NIDEK AFC-230 fundus camera; without pupil dilation — 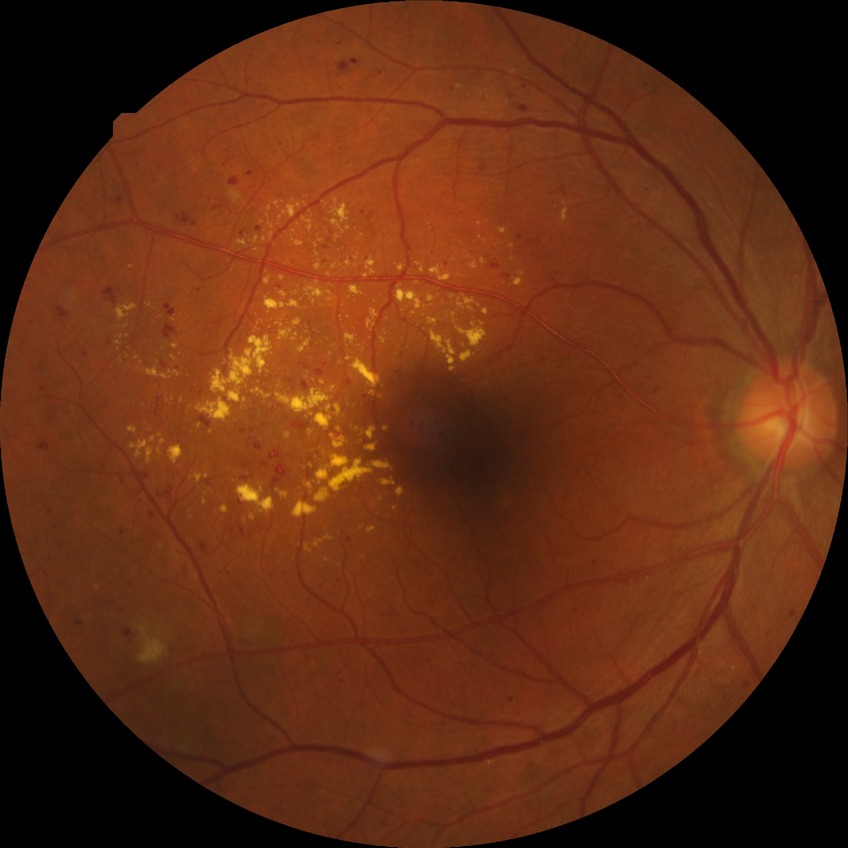 Diabetic retinopathy (DR): pre-proliferative diabetic retinopathy (PPDR).